Macula-centered — 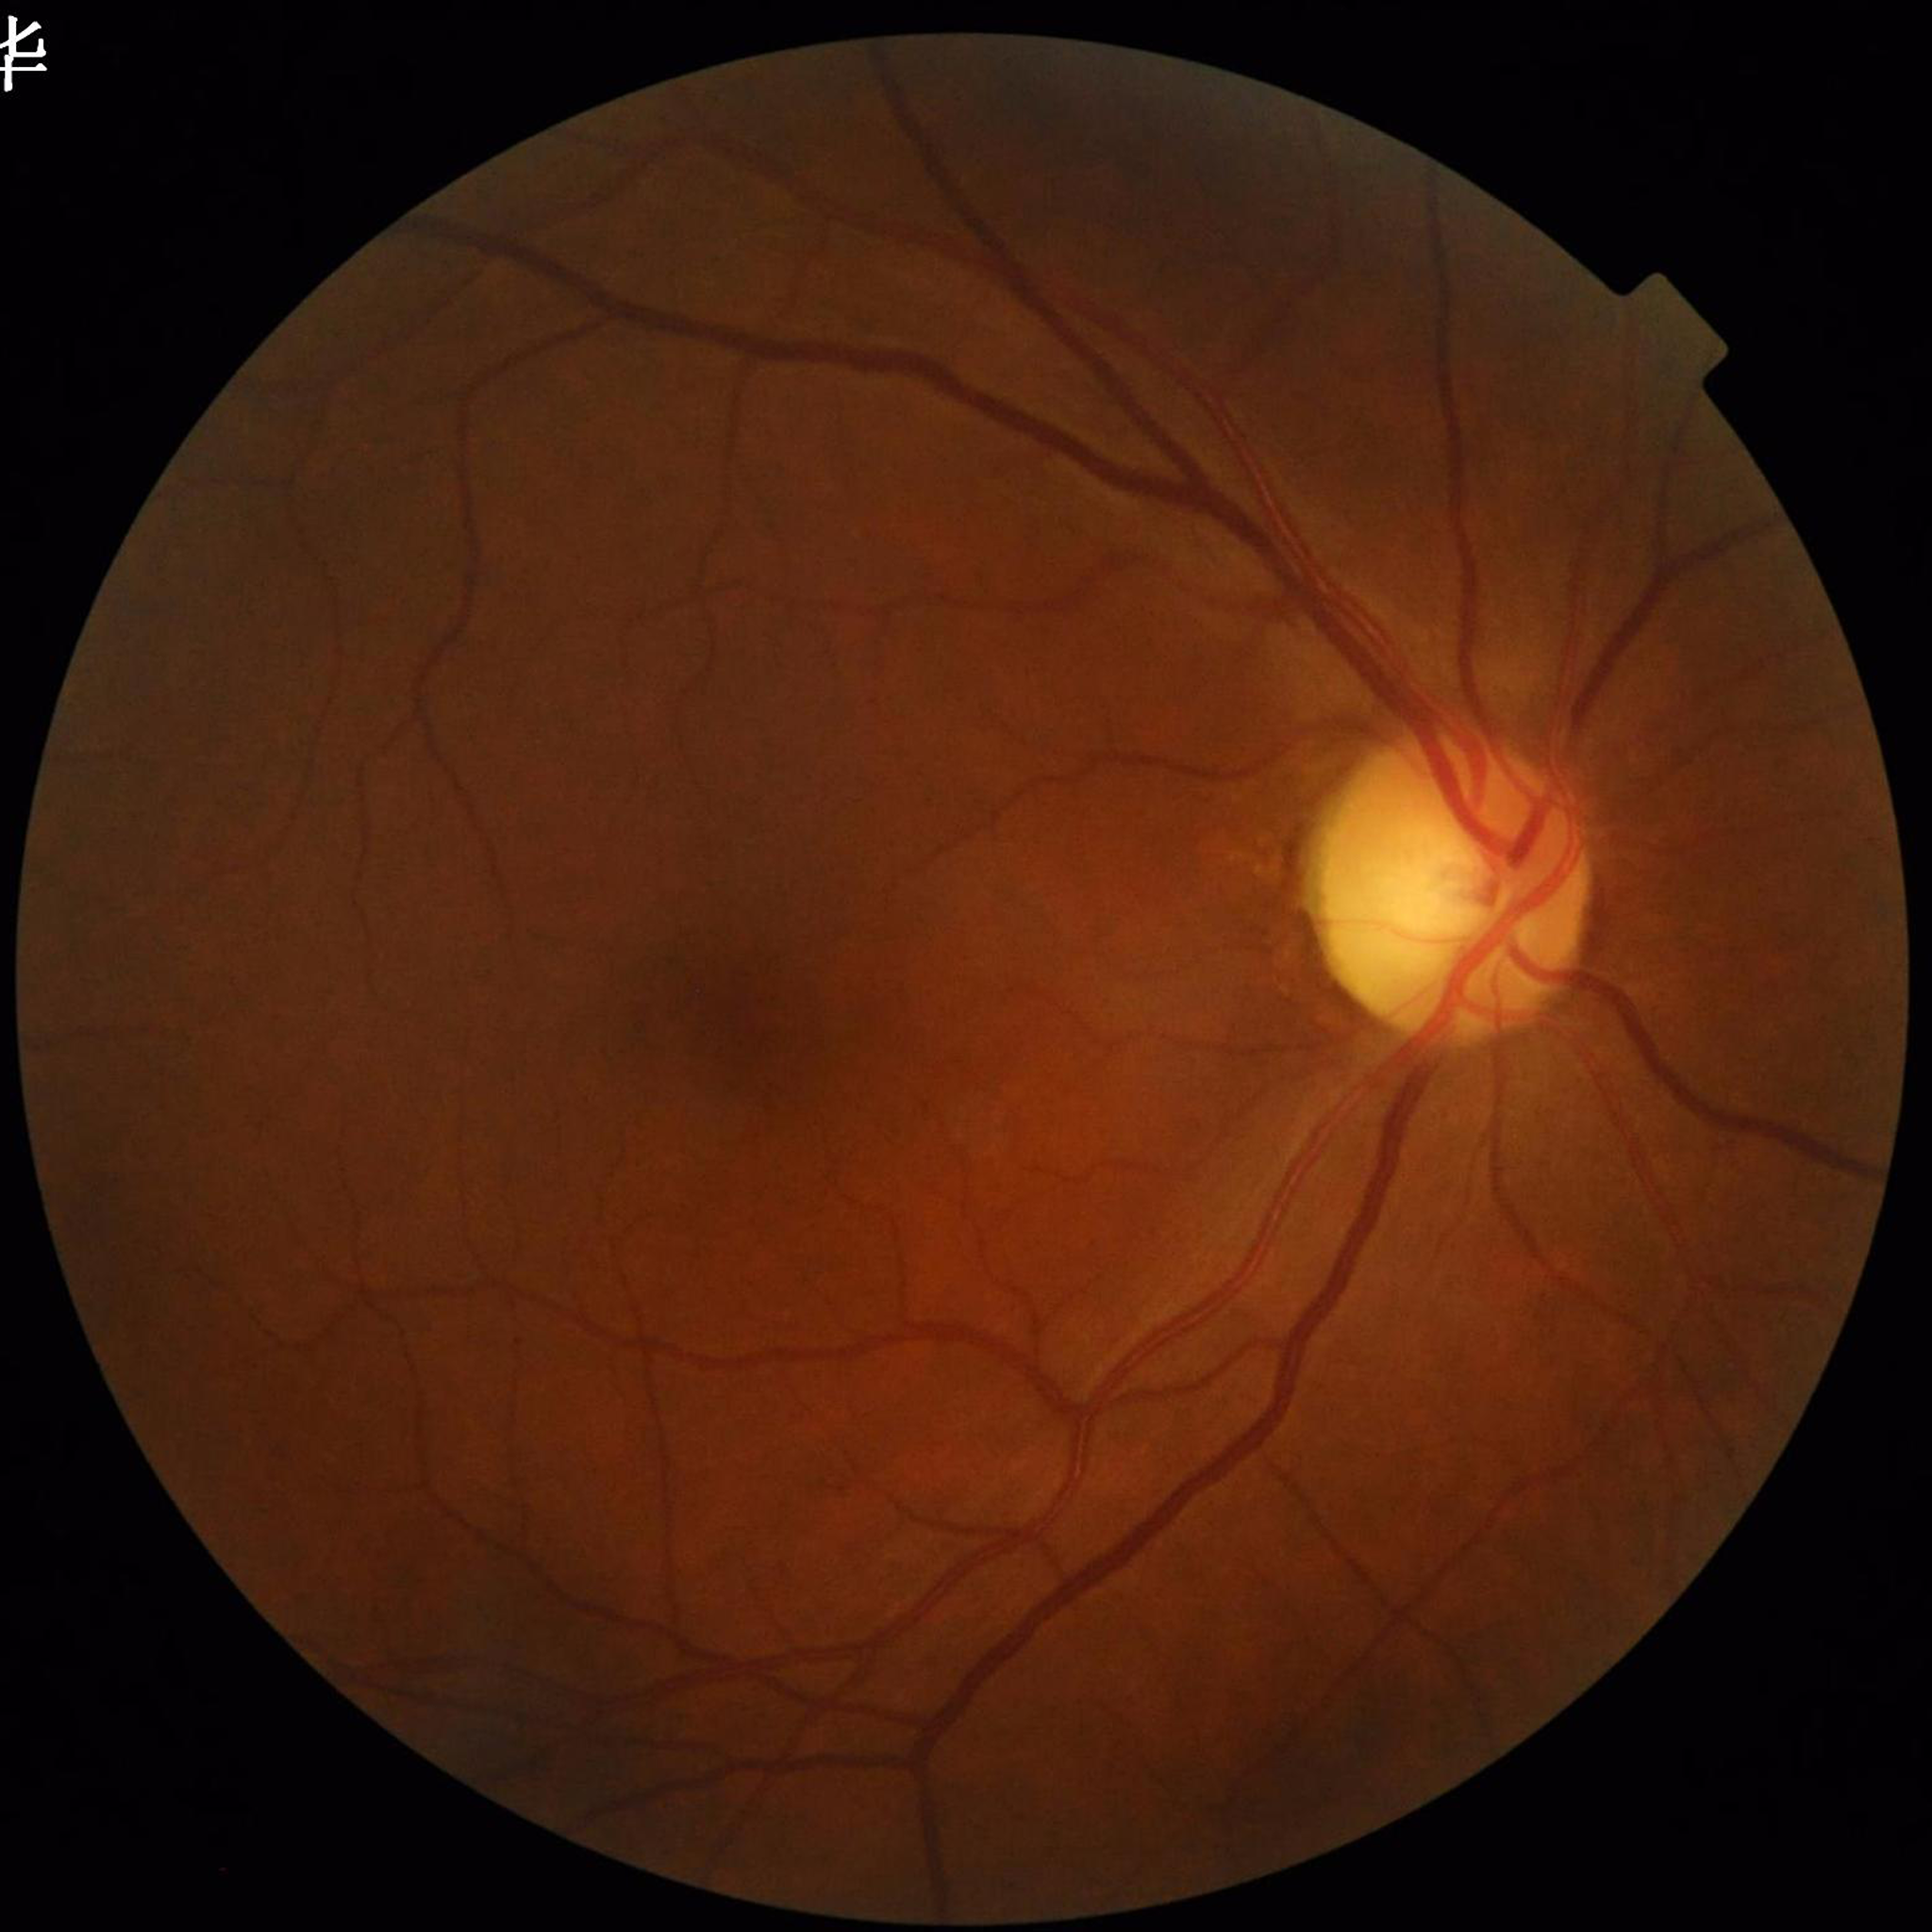

This fundus photograph is from a patient diagnosed with glaucoma.